Optic disc photograph — 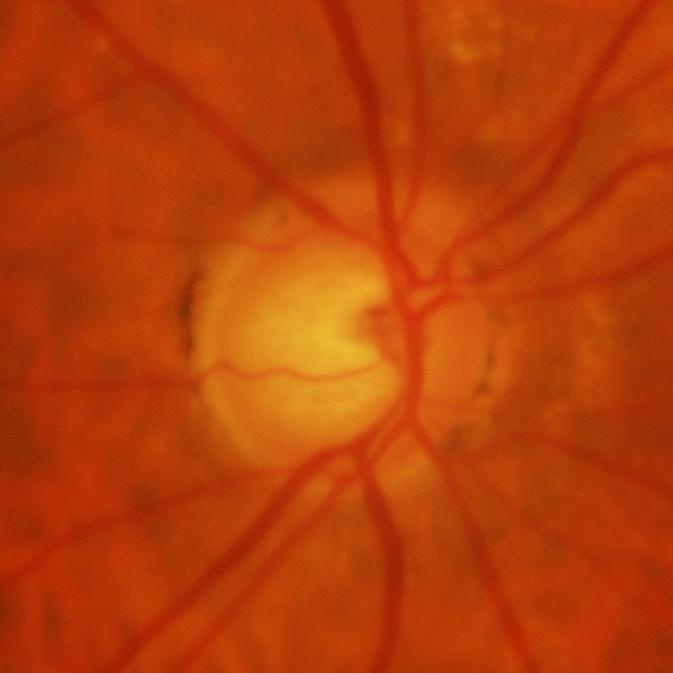
The image shows glaucomatous findings.